Without pupil dilation: 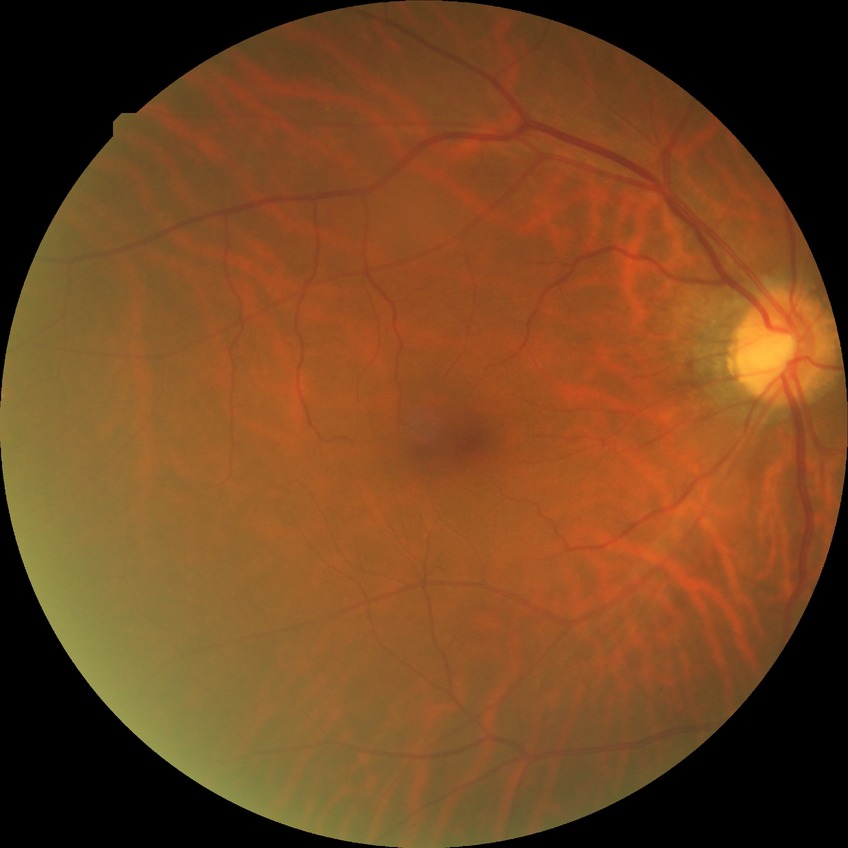 diabetic retinopathy (DR): SDR (simple diabetic retinopathy).